2352 x 1568 pixels; fundus photo; 45° field of view.
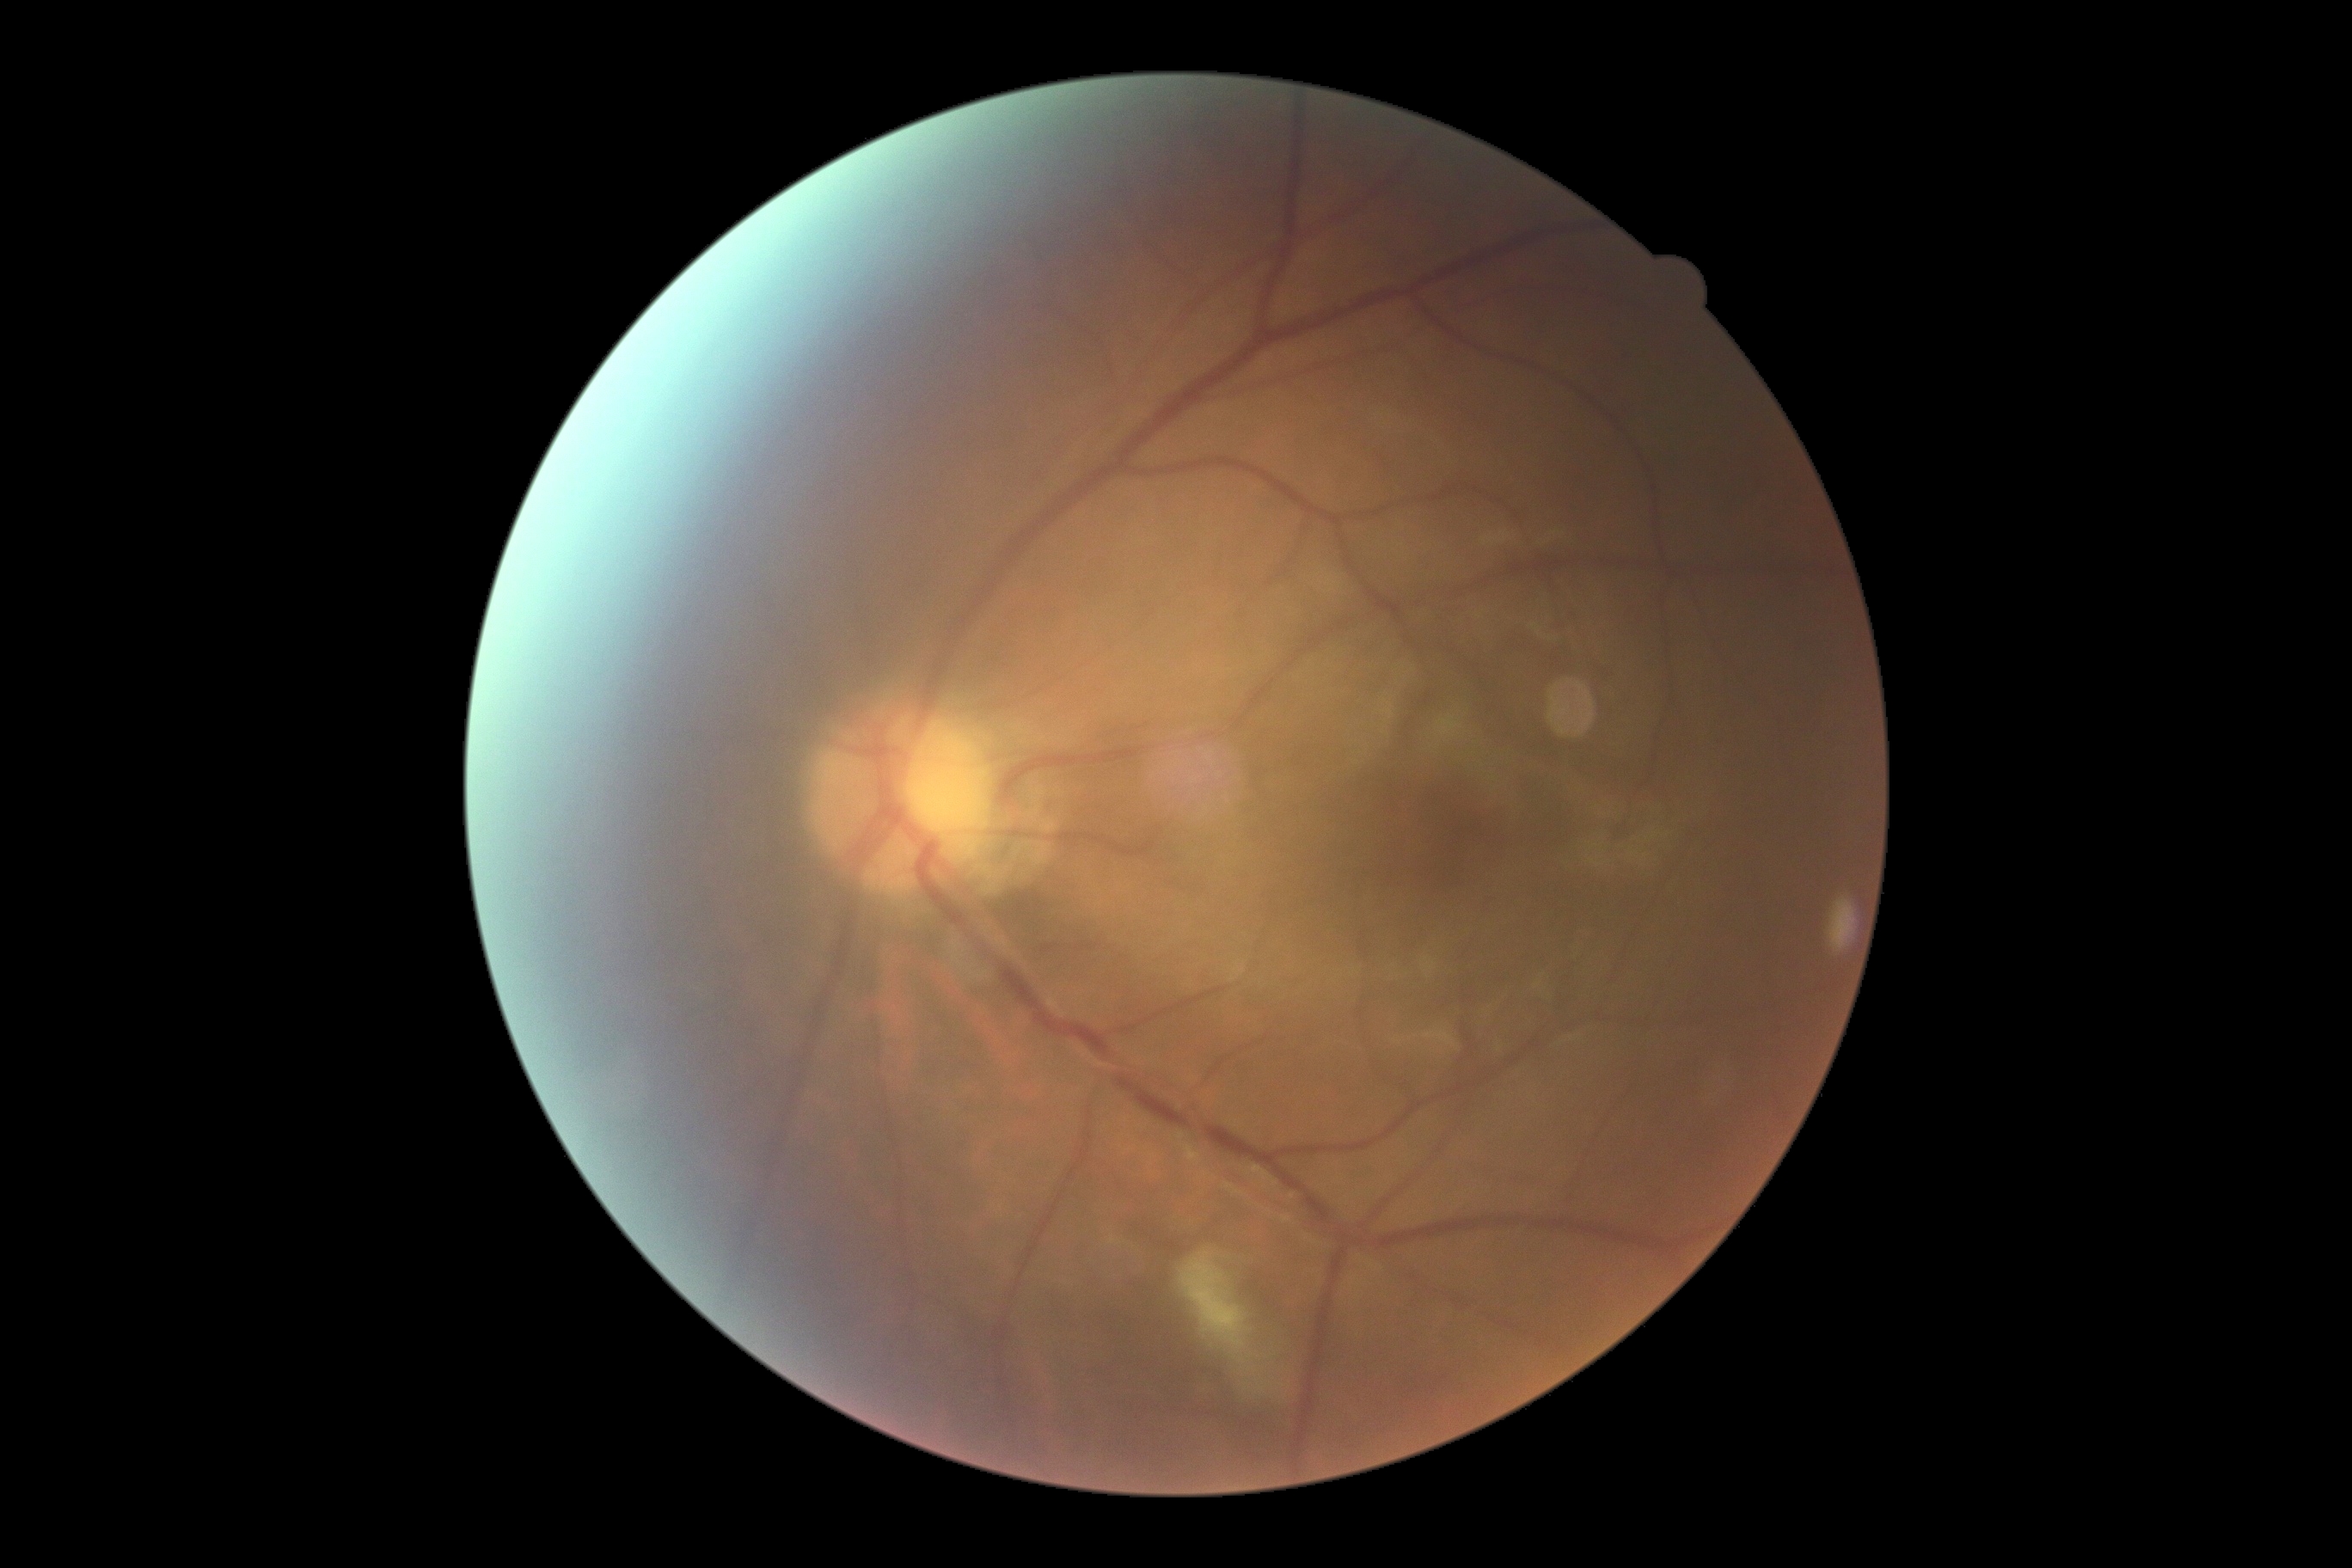
The retinopathy is classified as non-proliferative diabetic retinopathy.
Diabetic retinopathy (DR) is moderate NPDR (grade 2).